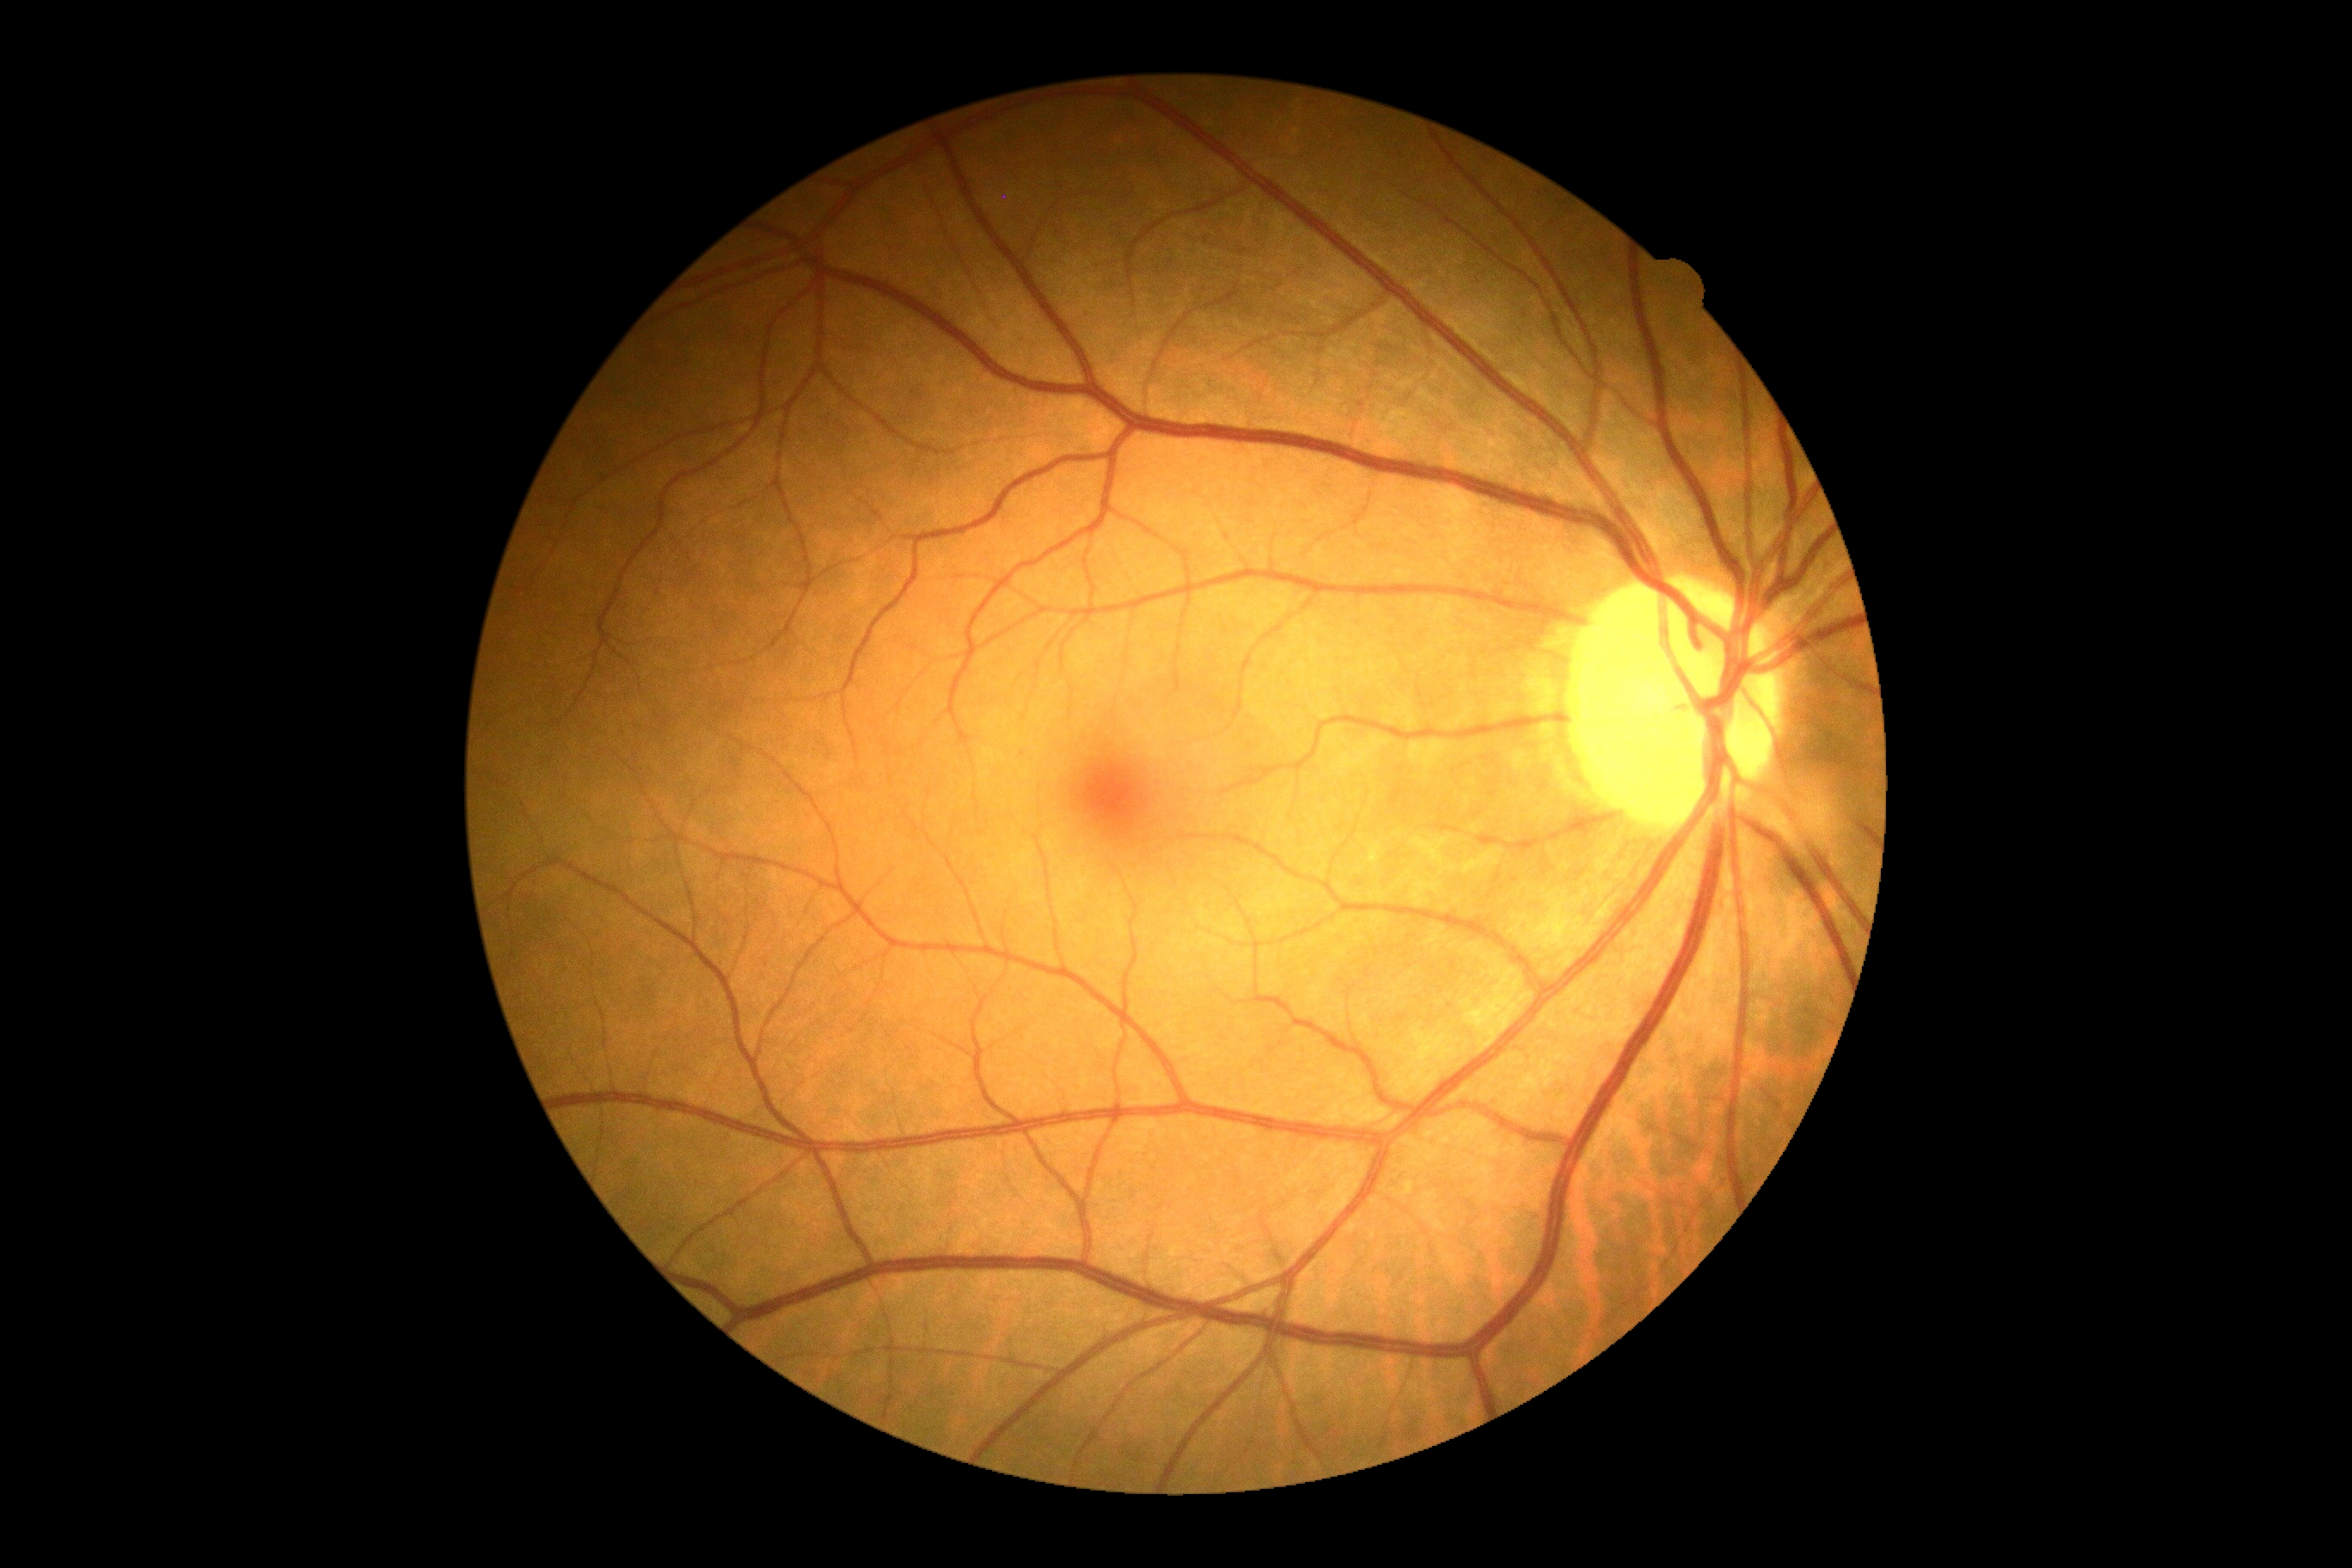
dr_impression: no DR findings
dr_grade: grade 0 (no apparent retinopathy)